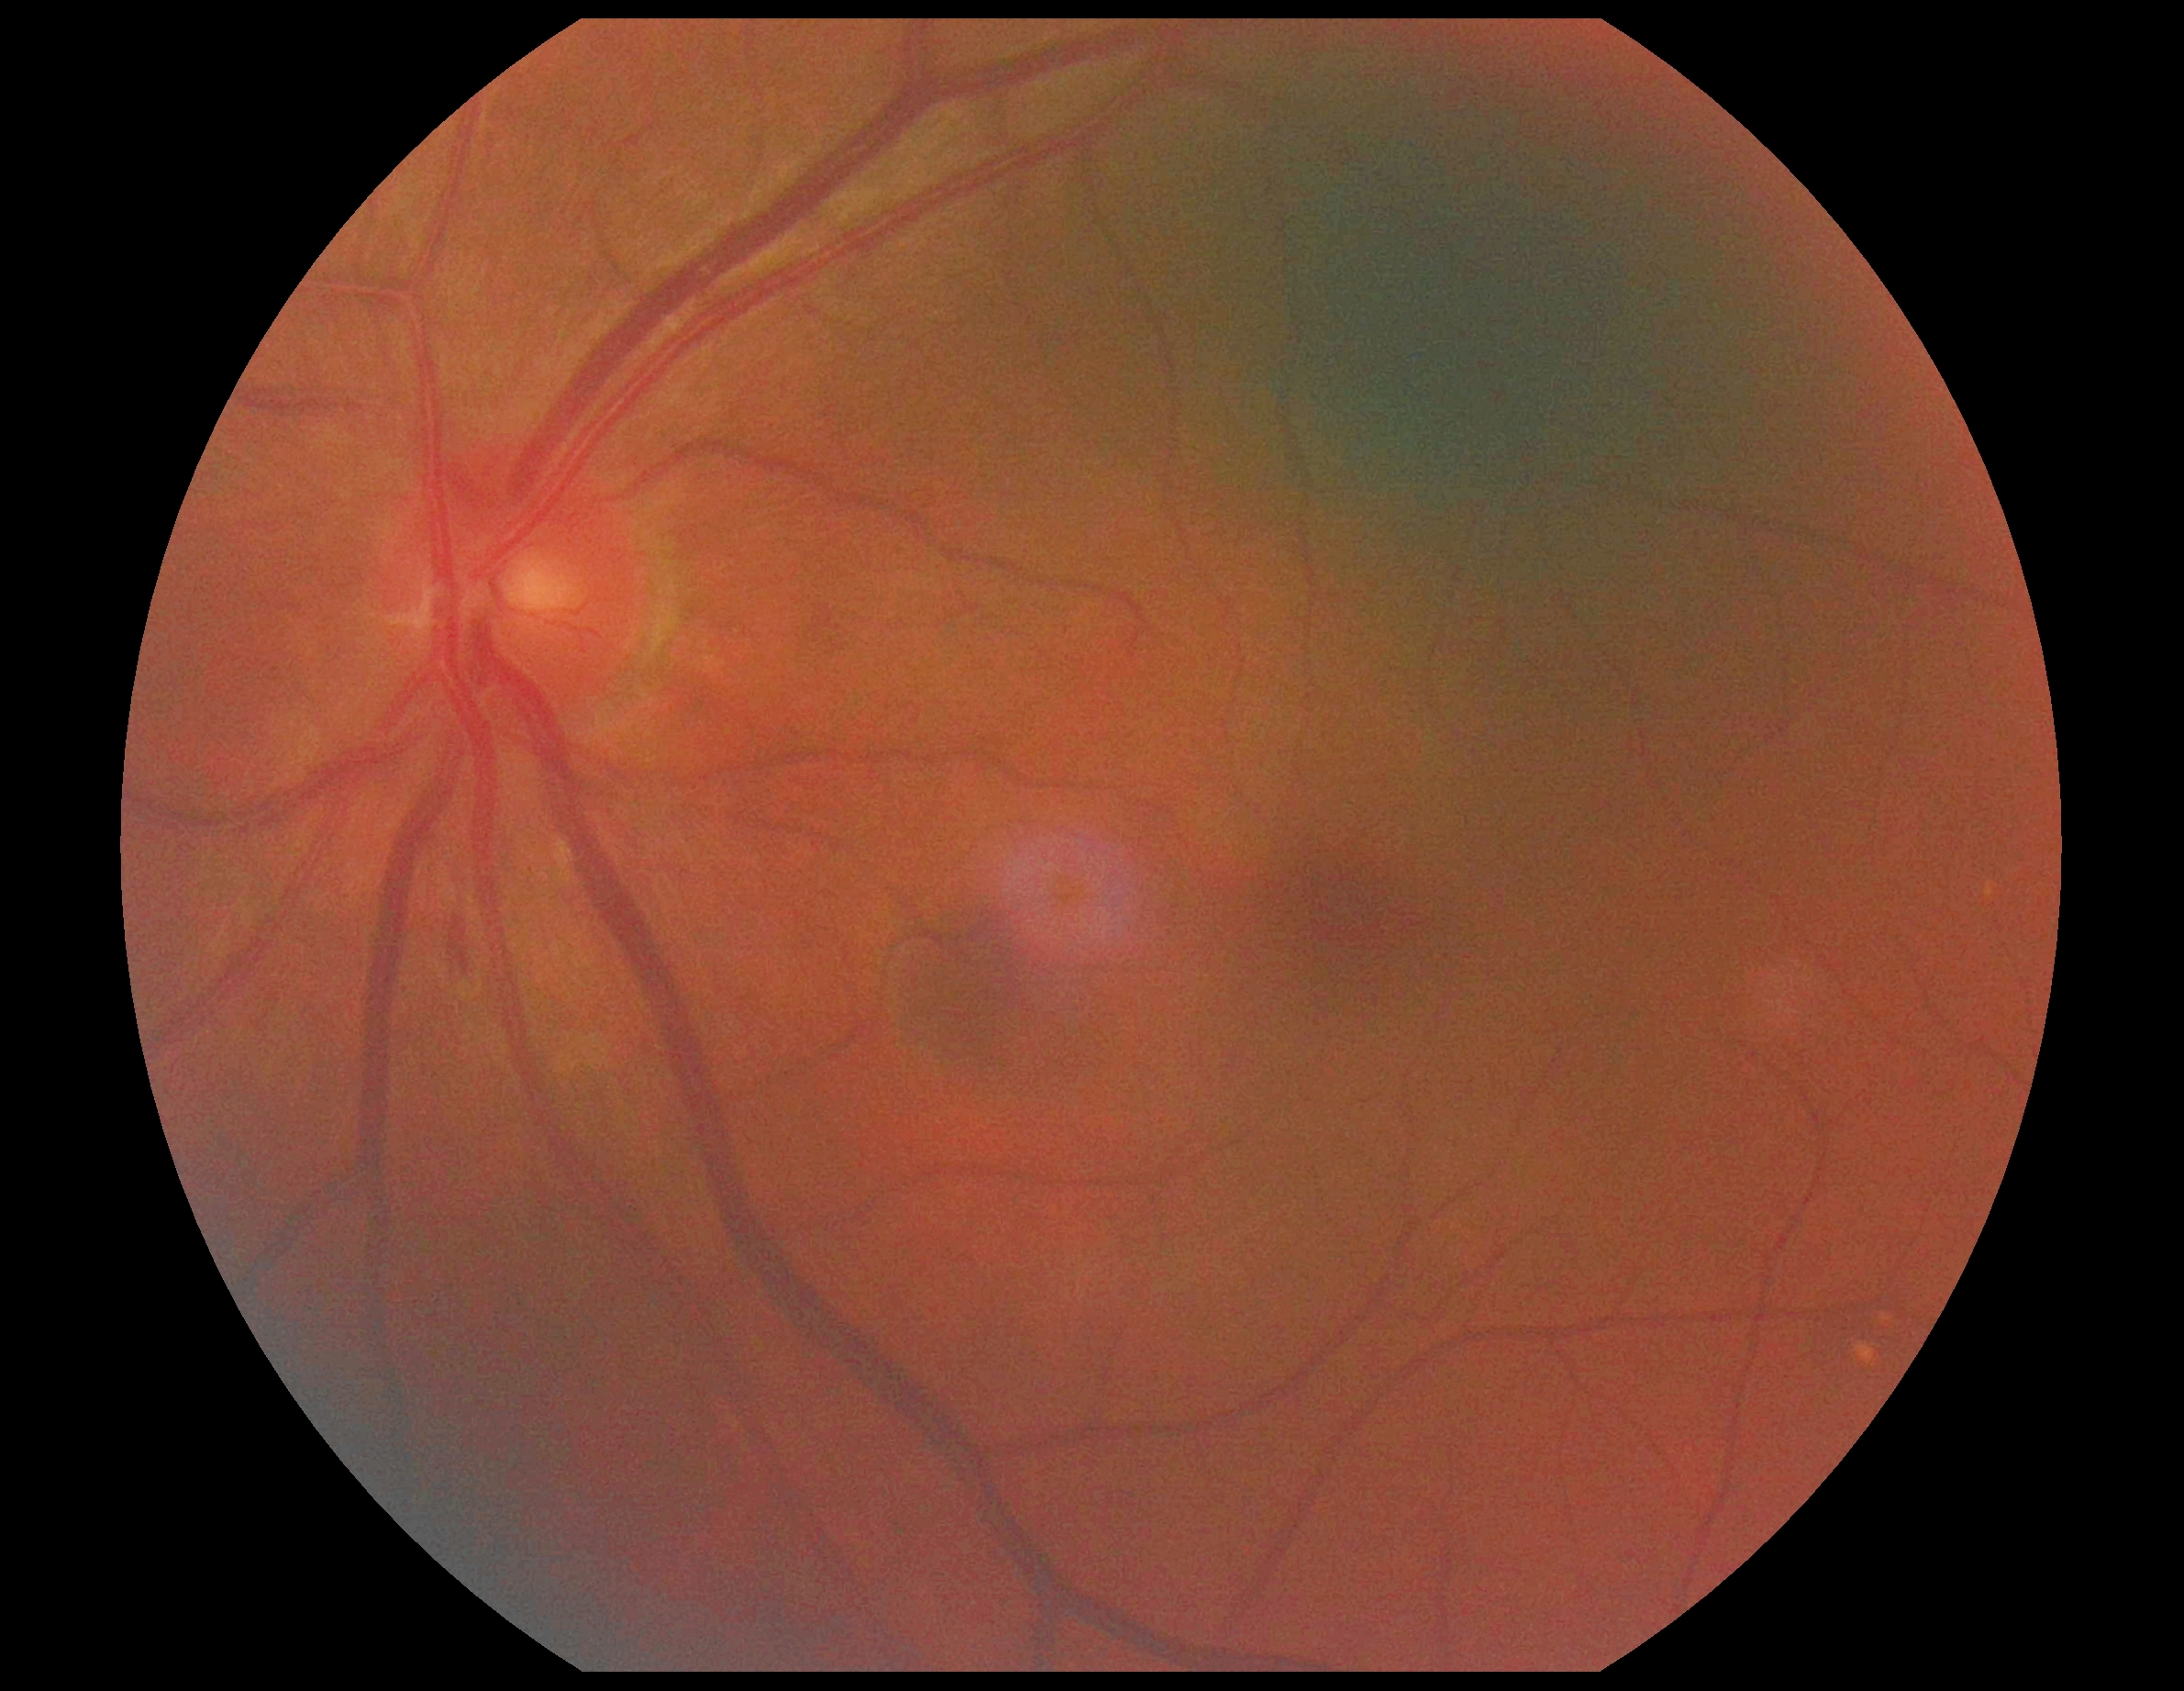

DR = moderate non-proliferative diabetic retinopathy (grade 2), DR class = non-proliferative diabetic retinopathy.